CFP. Nonmydriatic. Davis DR grading:
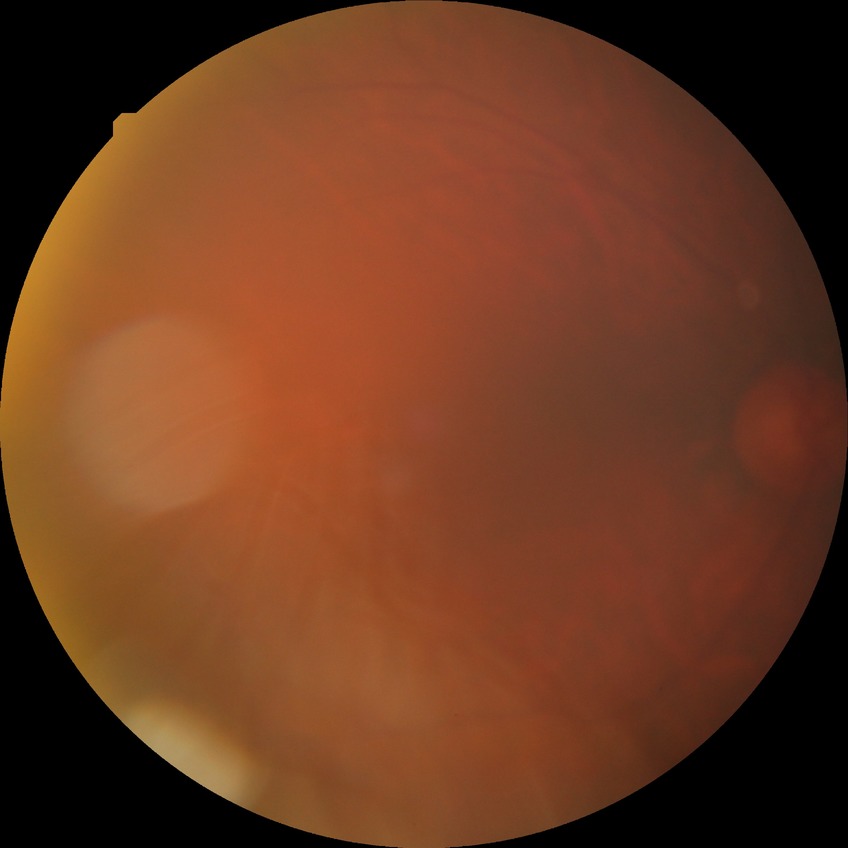

Davis grading = simple diabetic retinopathy